Diabetic retinopathy graded by the modified Davis classification.
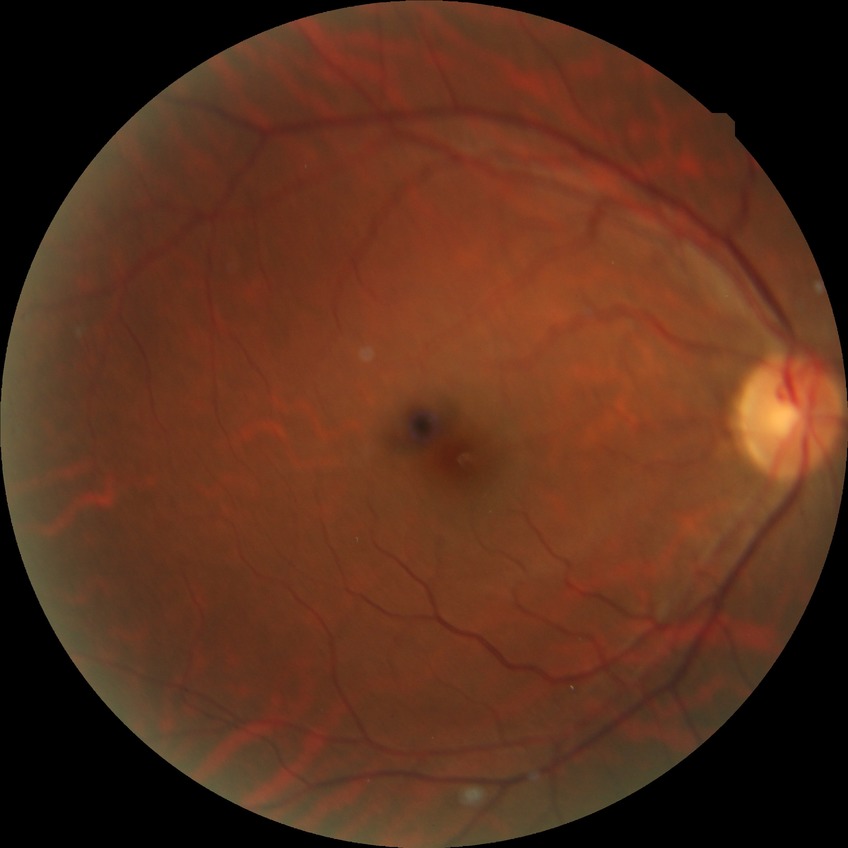
No diabetic retinal disease findings. DR is NDR.